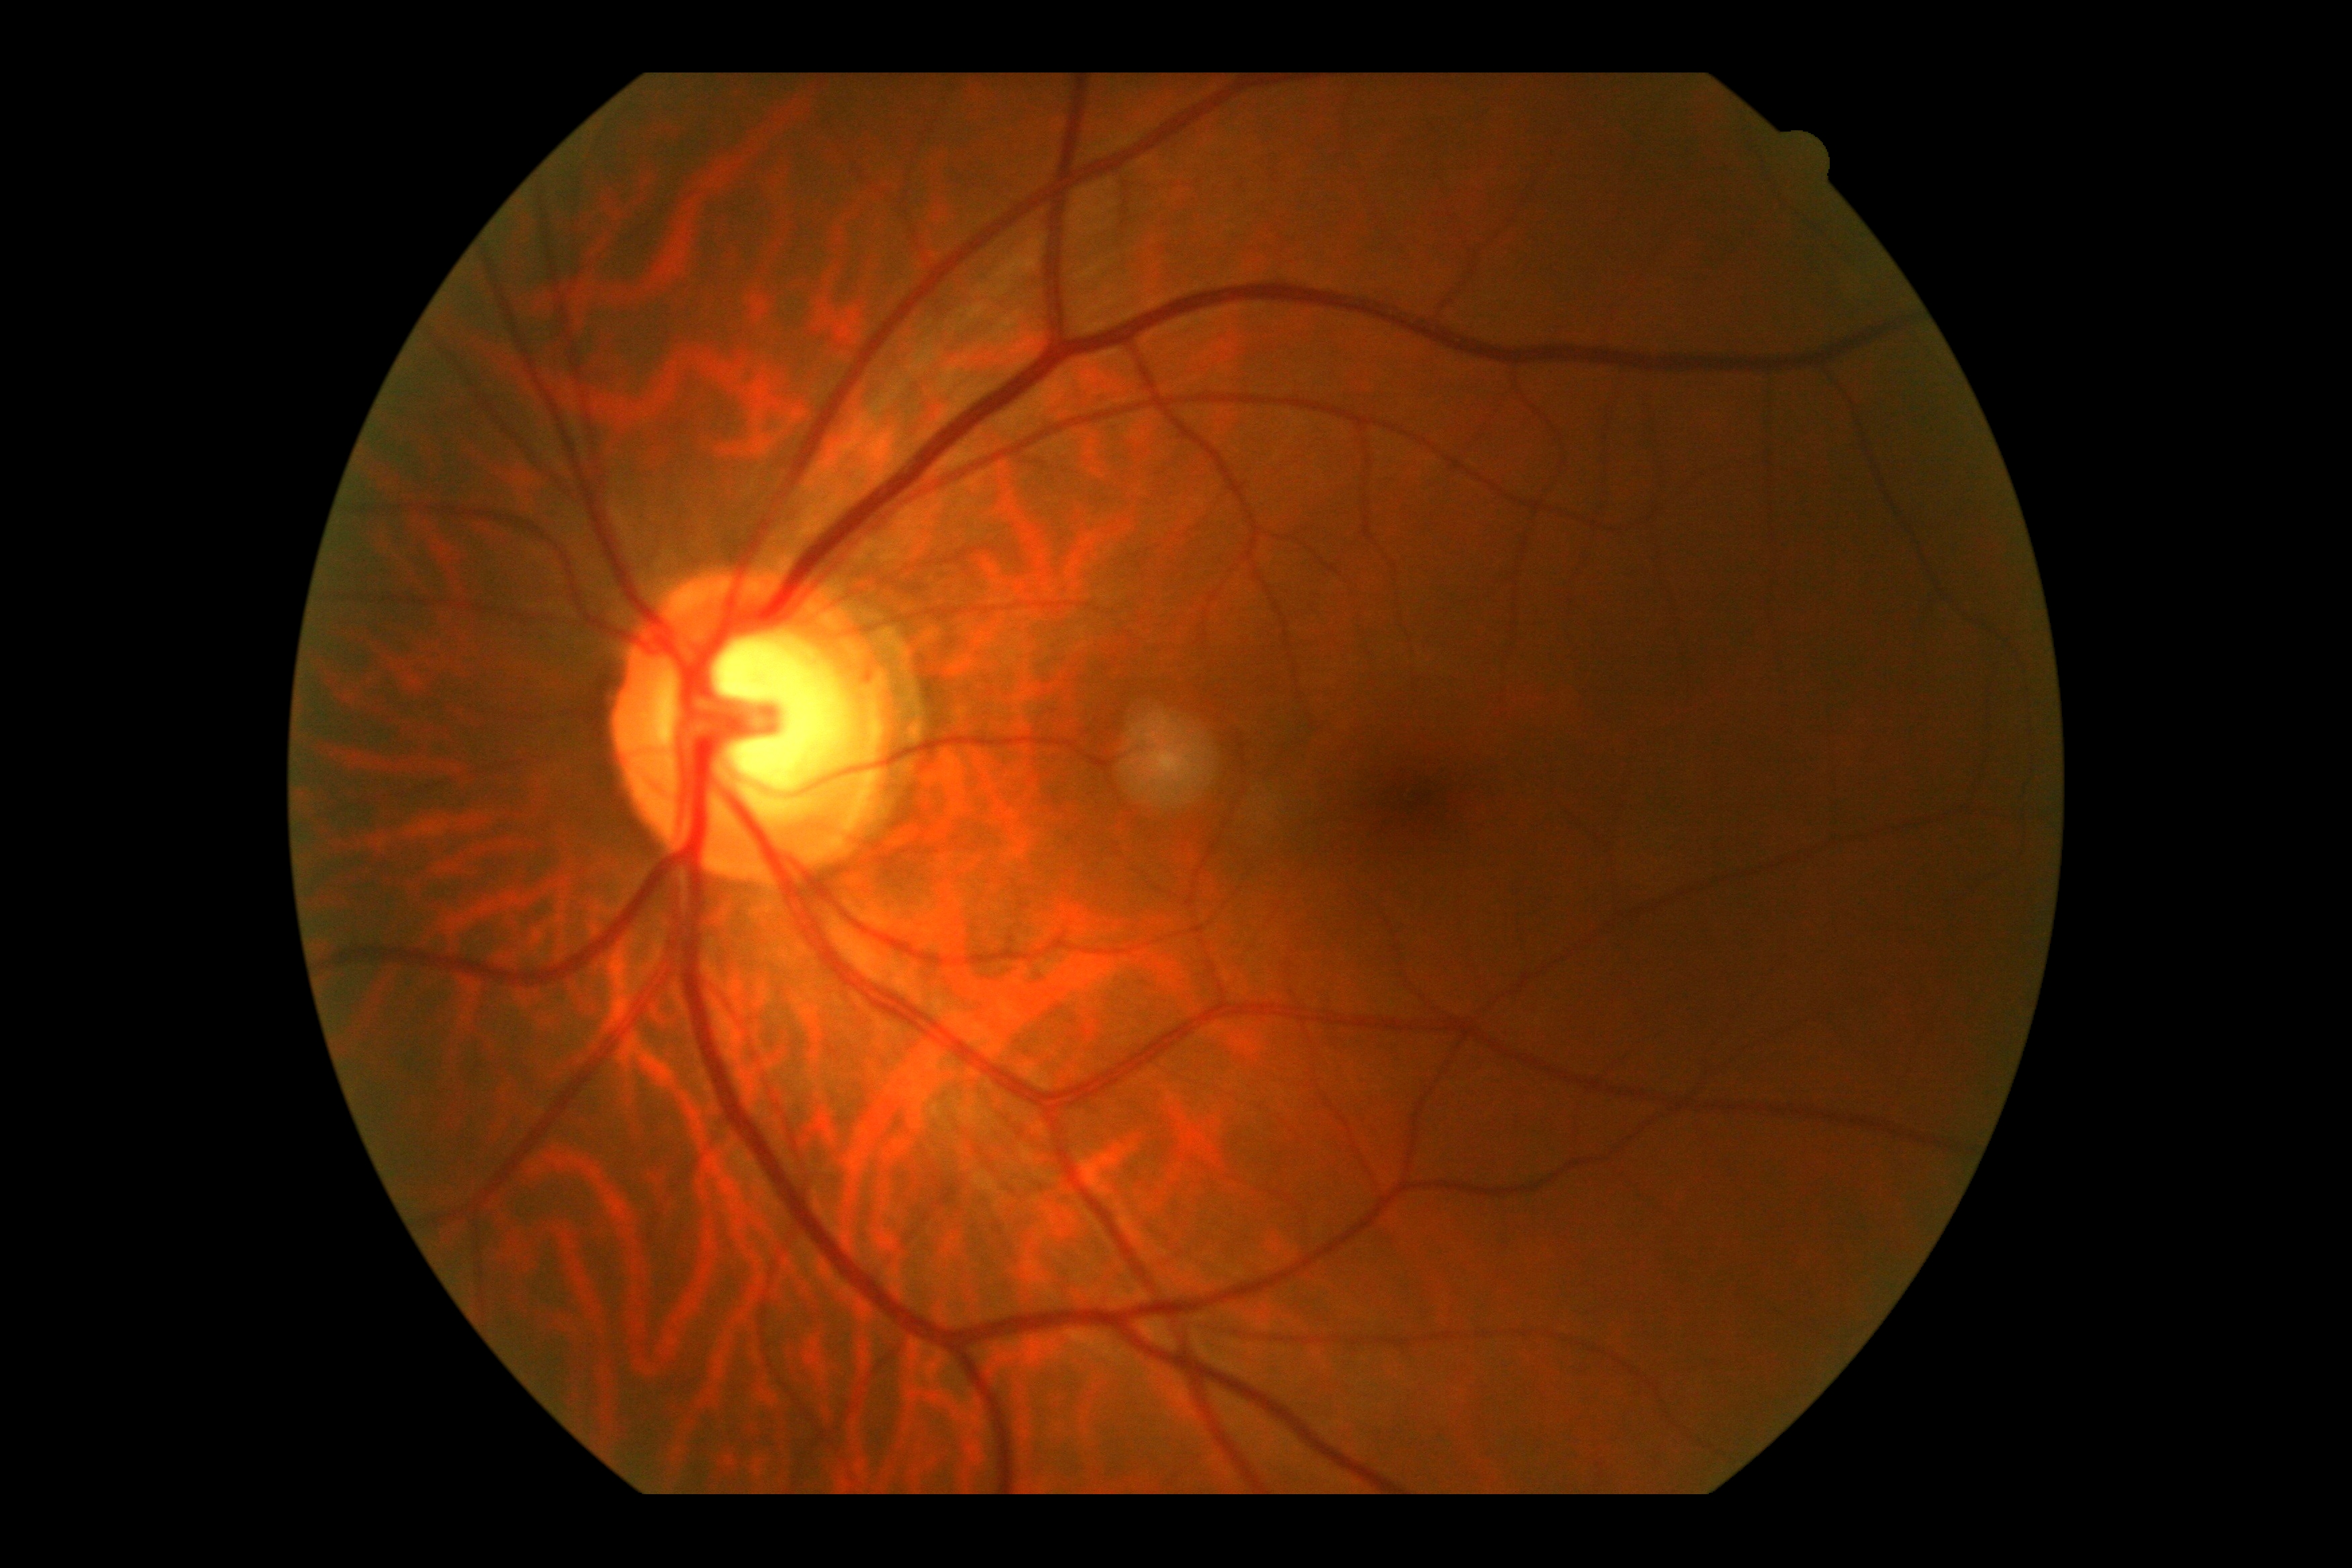

Retinopathy: 0.